Fundus photo. FOV: 45 degrees. 2352 x 1568 pixels: 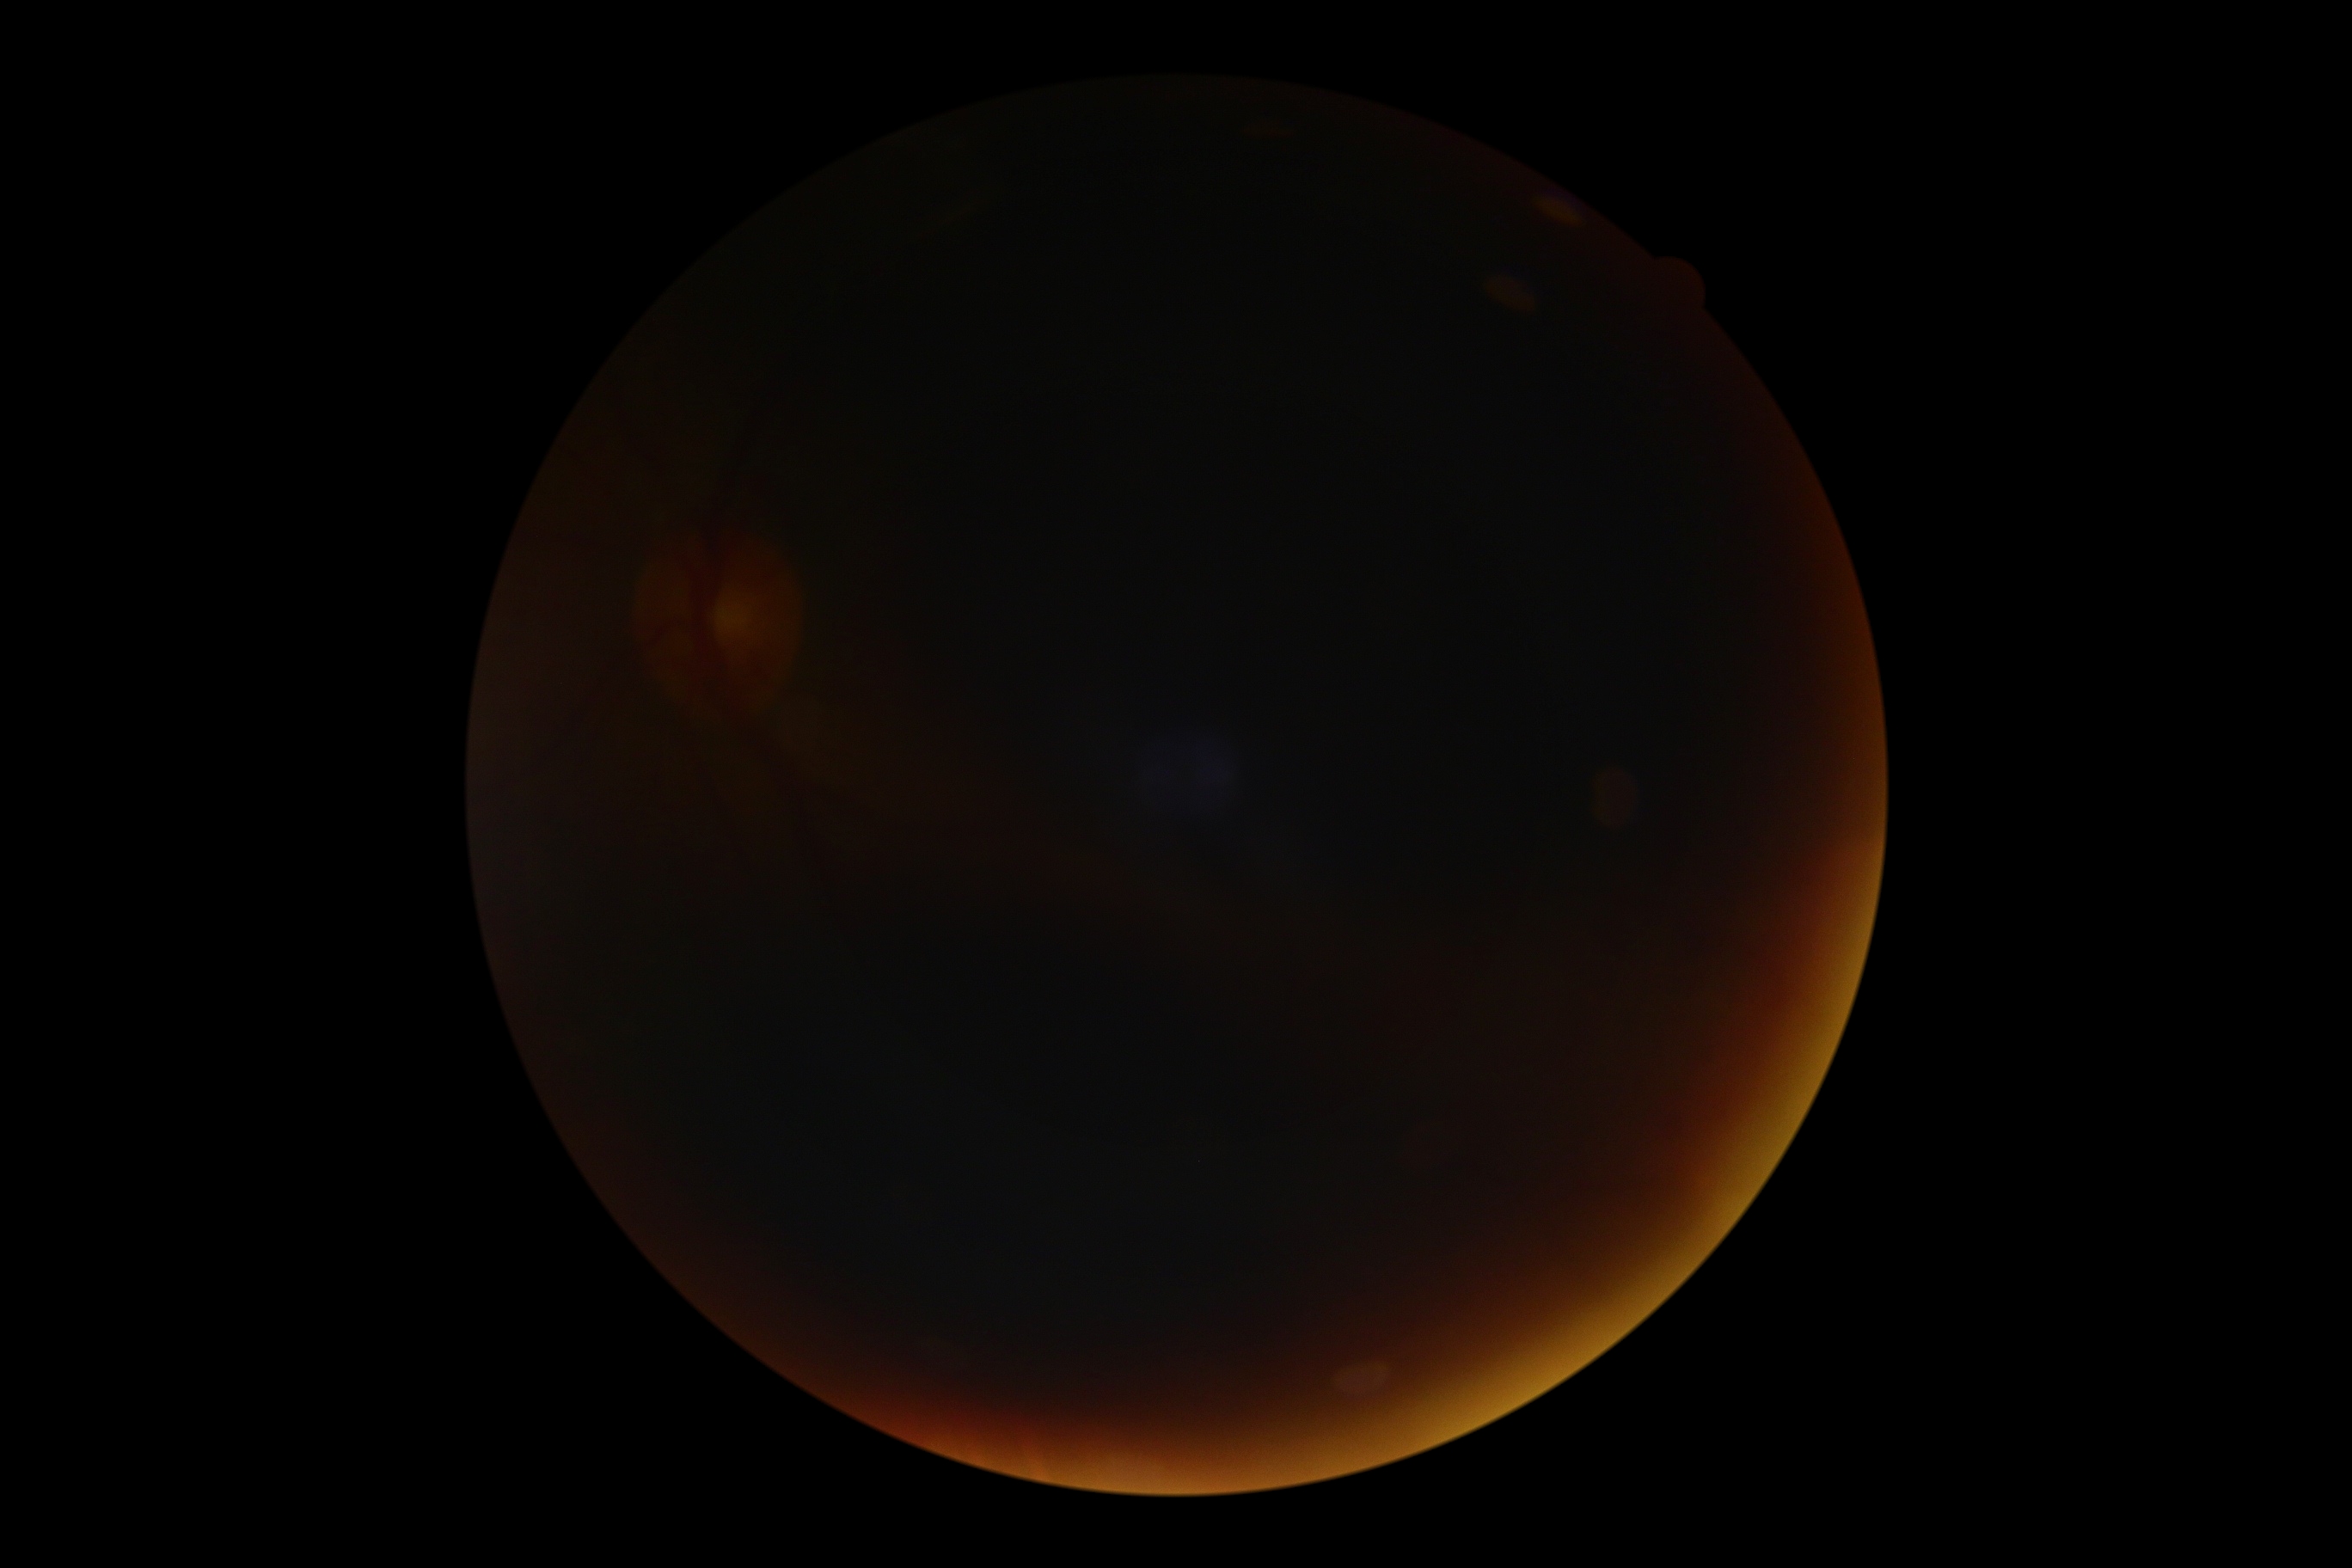
DR grade is ungradable due to poor image quality. Image quality is insufficient for diabetic retinopathy assessment.